1240x1240. Wide-field fundus image from infant ROP screening
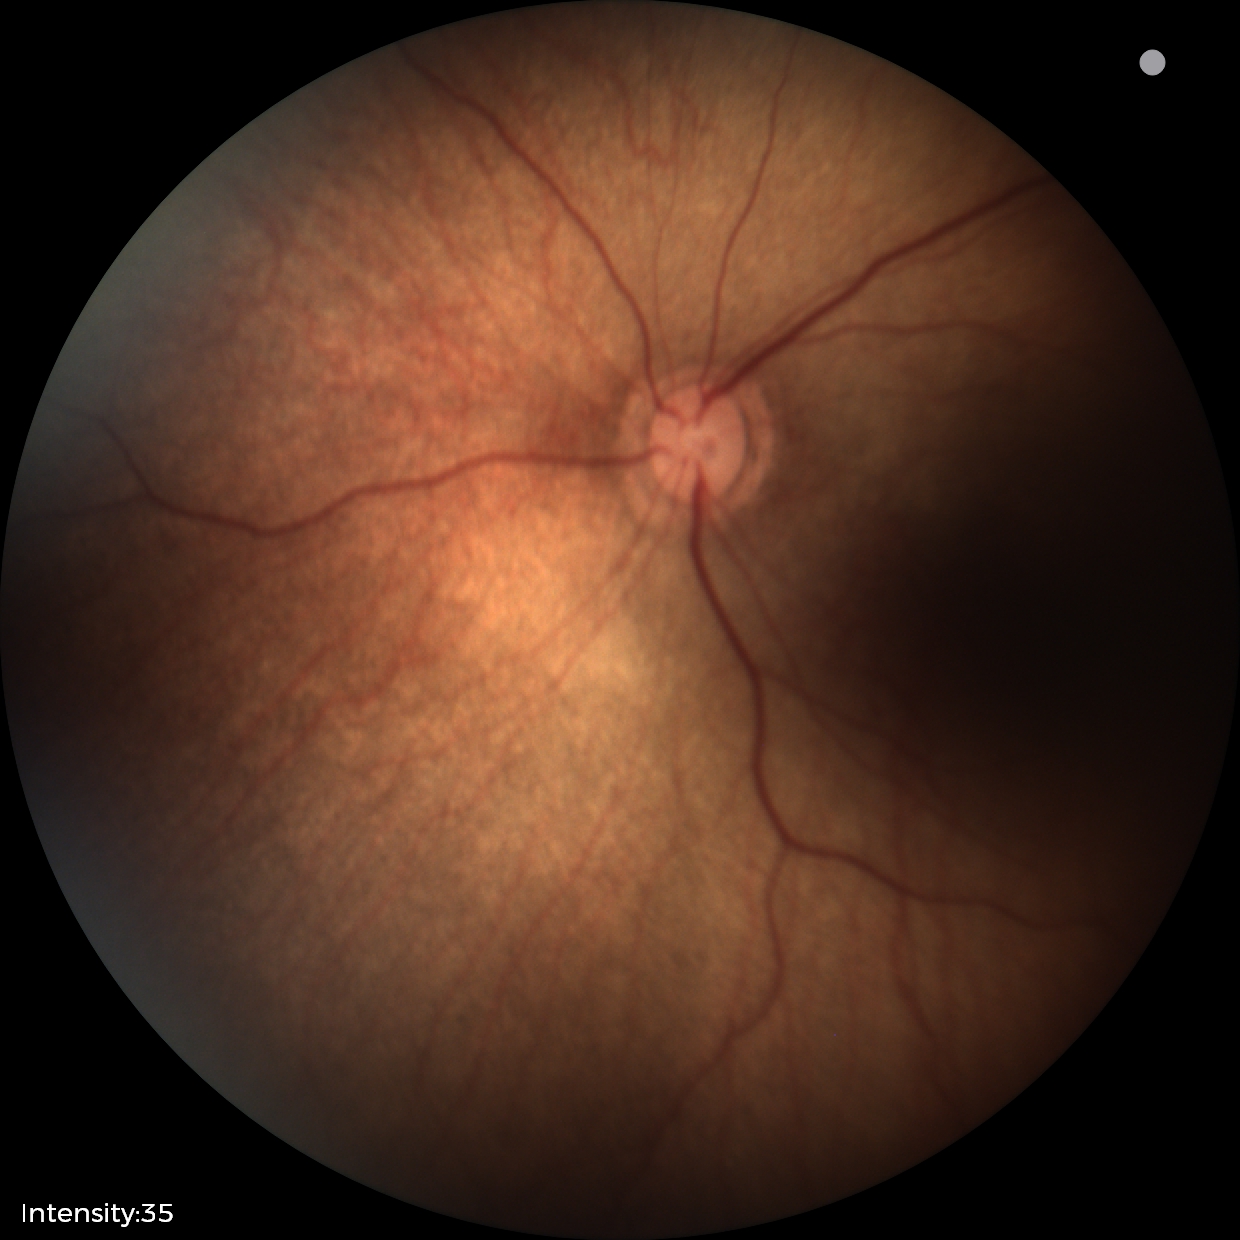

Physiological retinal appearance for postconceptual age.